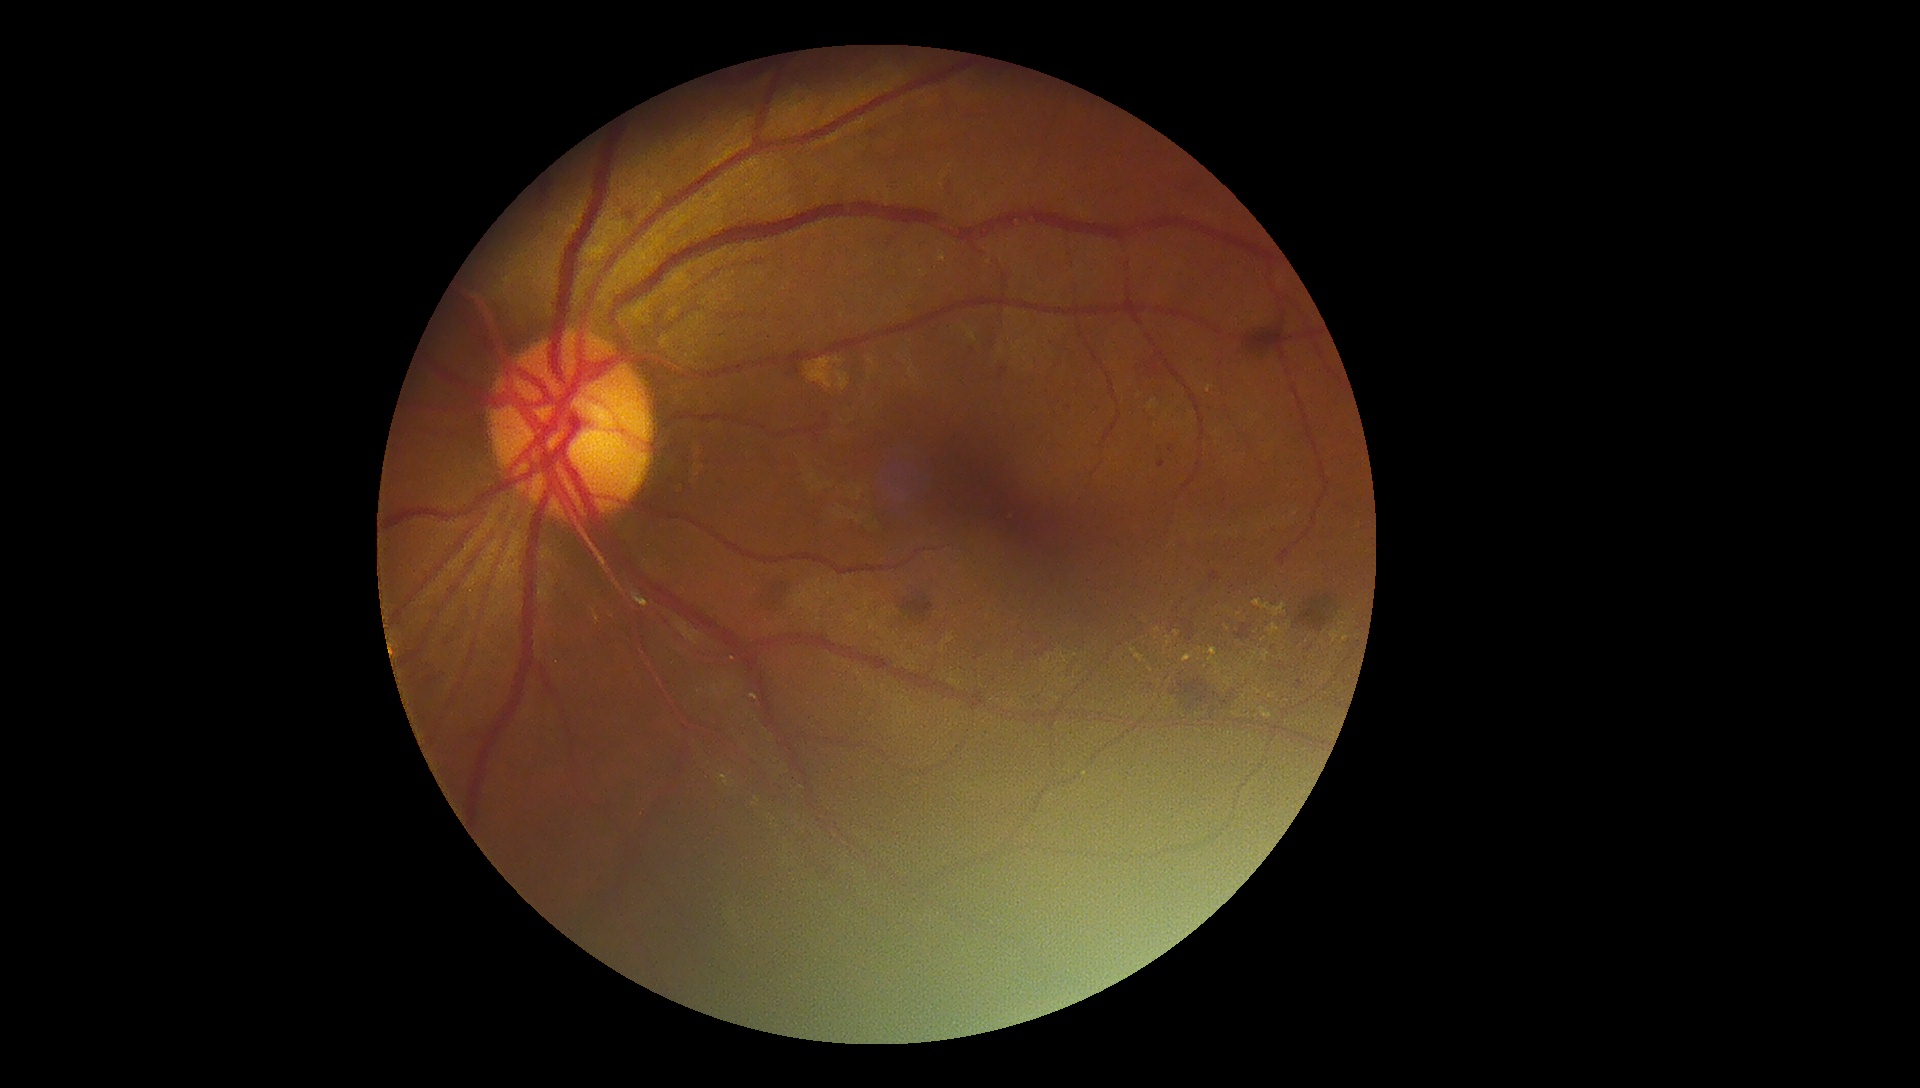 partial: true
dr_grade: 2
dr_grade_name: moderate NPDR
lesions:
  ma:
    - (left=1157, top=461, right=1166, bottom=468)
    - (left=1168, top=445, right=1175, bottom=454)
    - (left=998, top=367, right=1009, bottom=381)
    - (left=1294, top=680, right=1304, bottom=691)
  ma_small_approx:
    - <pt>1158,449</pt>
    - <pt>1052,343</pt>
    - <pt>1069,408</pt>
  ex:
    - (left=1260, top=708, right=1273, bottom=719)
    - (left=1249, top=657, right=1255, bottom=667)
    - (left=1206, top=386, right=1214, bottom=394)
    - (left=1267, top=624, right=1280, bottom=637)
    - (left=1164, top=637, right=1172, bottom=651)
    - (left=1204, top=648, right=1220, bottom=670)
    - (left=836, top=372, right=849, bottom=391)
    - (left=806, top=358, right=843, bottom=389)
  ex_small_approx:
    - <pt>1150,670</pt>
    - <pt>1228,685</pt>
    - <pt>1174,701</pt>
    - <pt>1168,710</pt>
    - <pt>1270,697</pt>
    - <pt>1160,707</pt>
    - <pt>1346,638</pt>
    - <pt>1166,700</pt>
    - <pt>1324,632</pt>
    - <pt>1169,681</pt>
    - <pt>1307,642</pt>
    - <pt>1263,640</pt>
  he:
    - (left=626, top=213, right=639, bottom=225)
    - (left=1210, top=571, right=1222, bottom=584)
    - (left=1186, top=622, right=1195, bottom=642)
    - (left=899, top=596, right=938, bottom=625)
    - (left=1138, top=356, right=1165, bottom=380)
    - (left=411, top=659, right=440, bottom=715)
    - (left=1296, top=599, right=1332, bottom=635)
    - (left=1234, top=624, right=1255, bottom=642)
    - (left=759, top=578, right=786, bottom=611)
    - (left=1174, top=679, right=1233, bottom=717)
  se: []